Fundus photo.
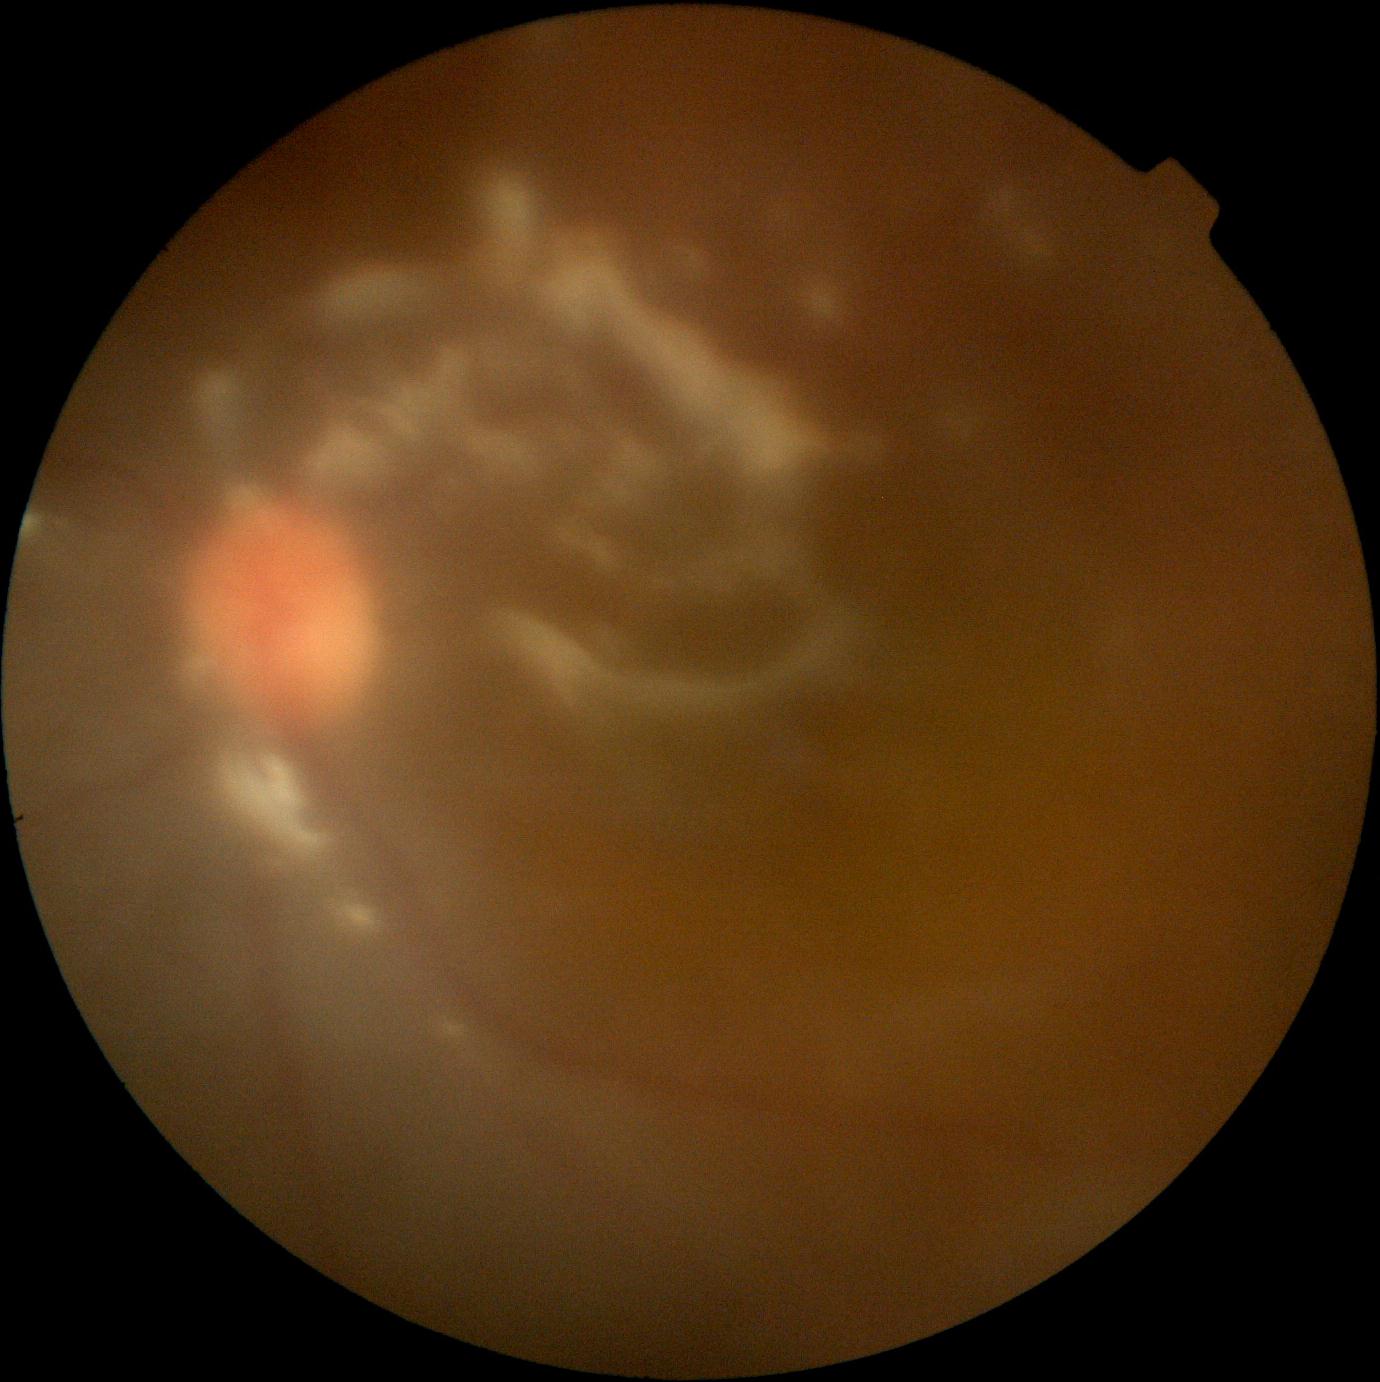
The image cannot be graded for diabetic retinopathy.
DR stage is ungradable.